Camera: Topcon TRC-50DX, pupil-dilated, 50-degree field of view, 2228 by 1652 pixels:
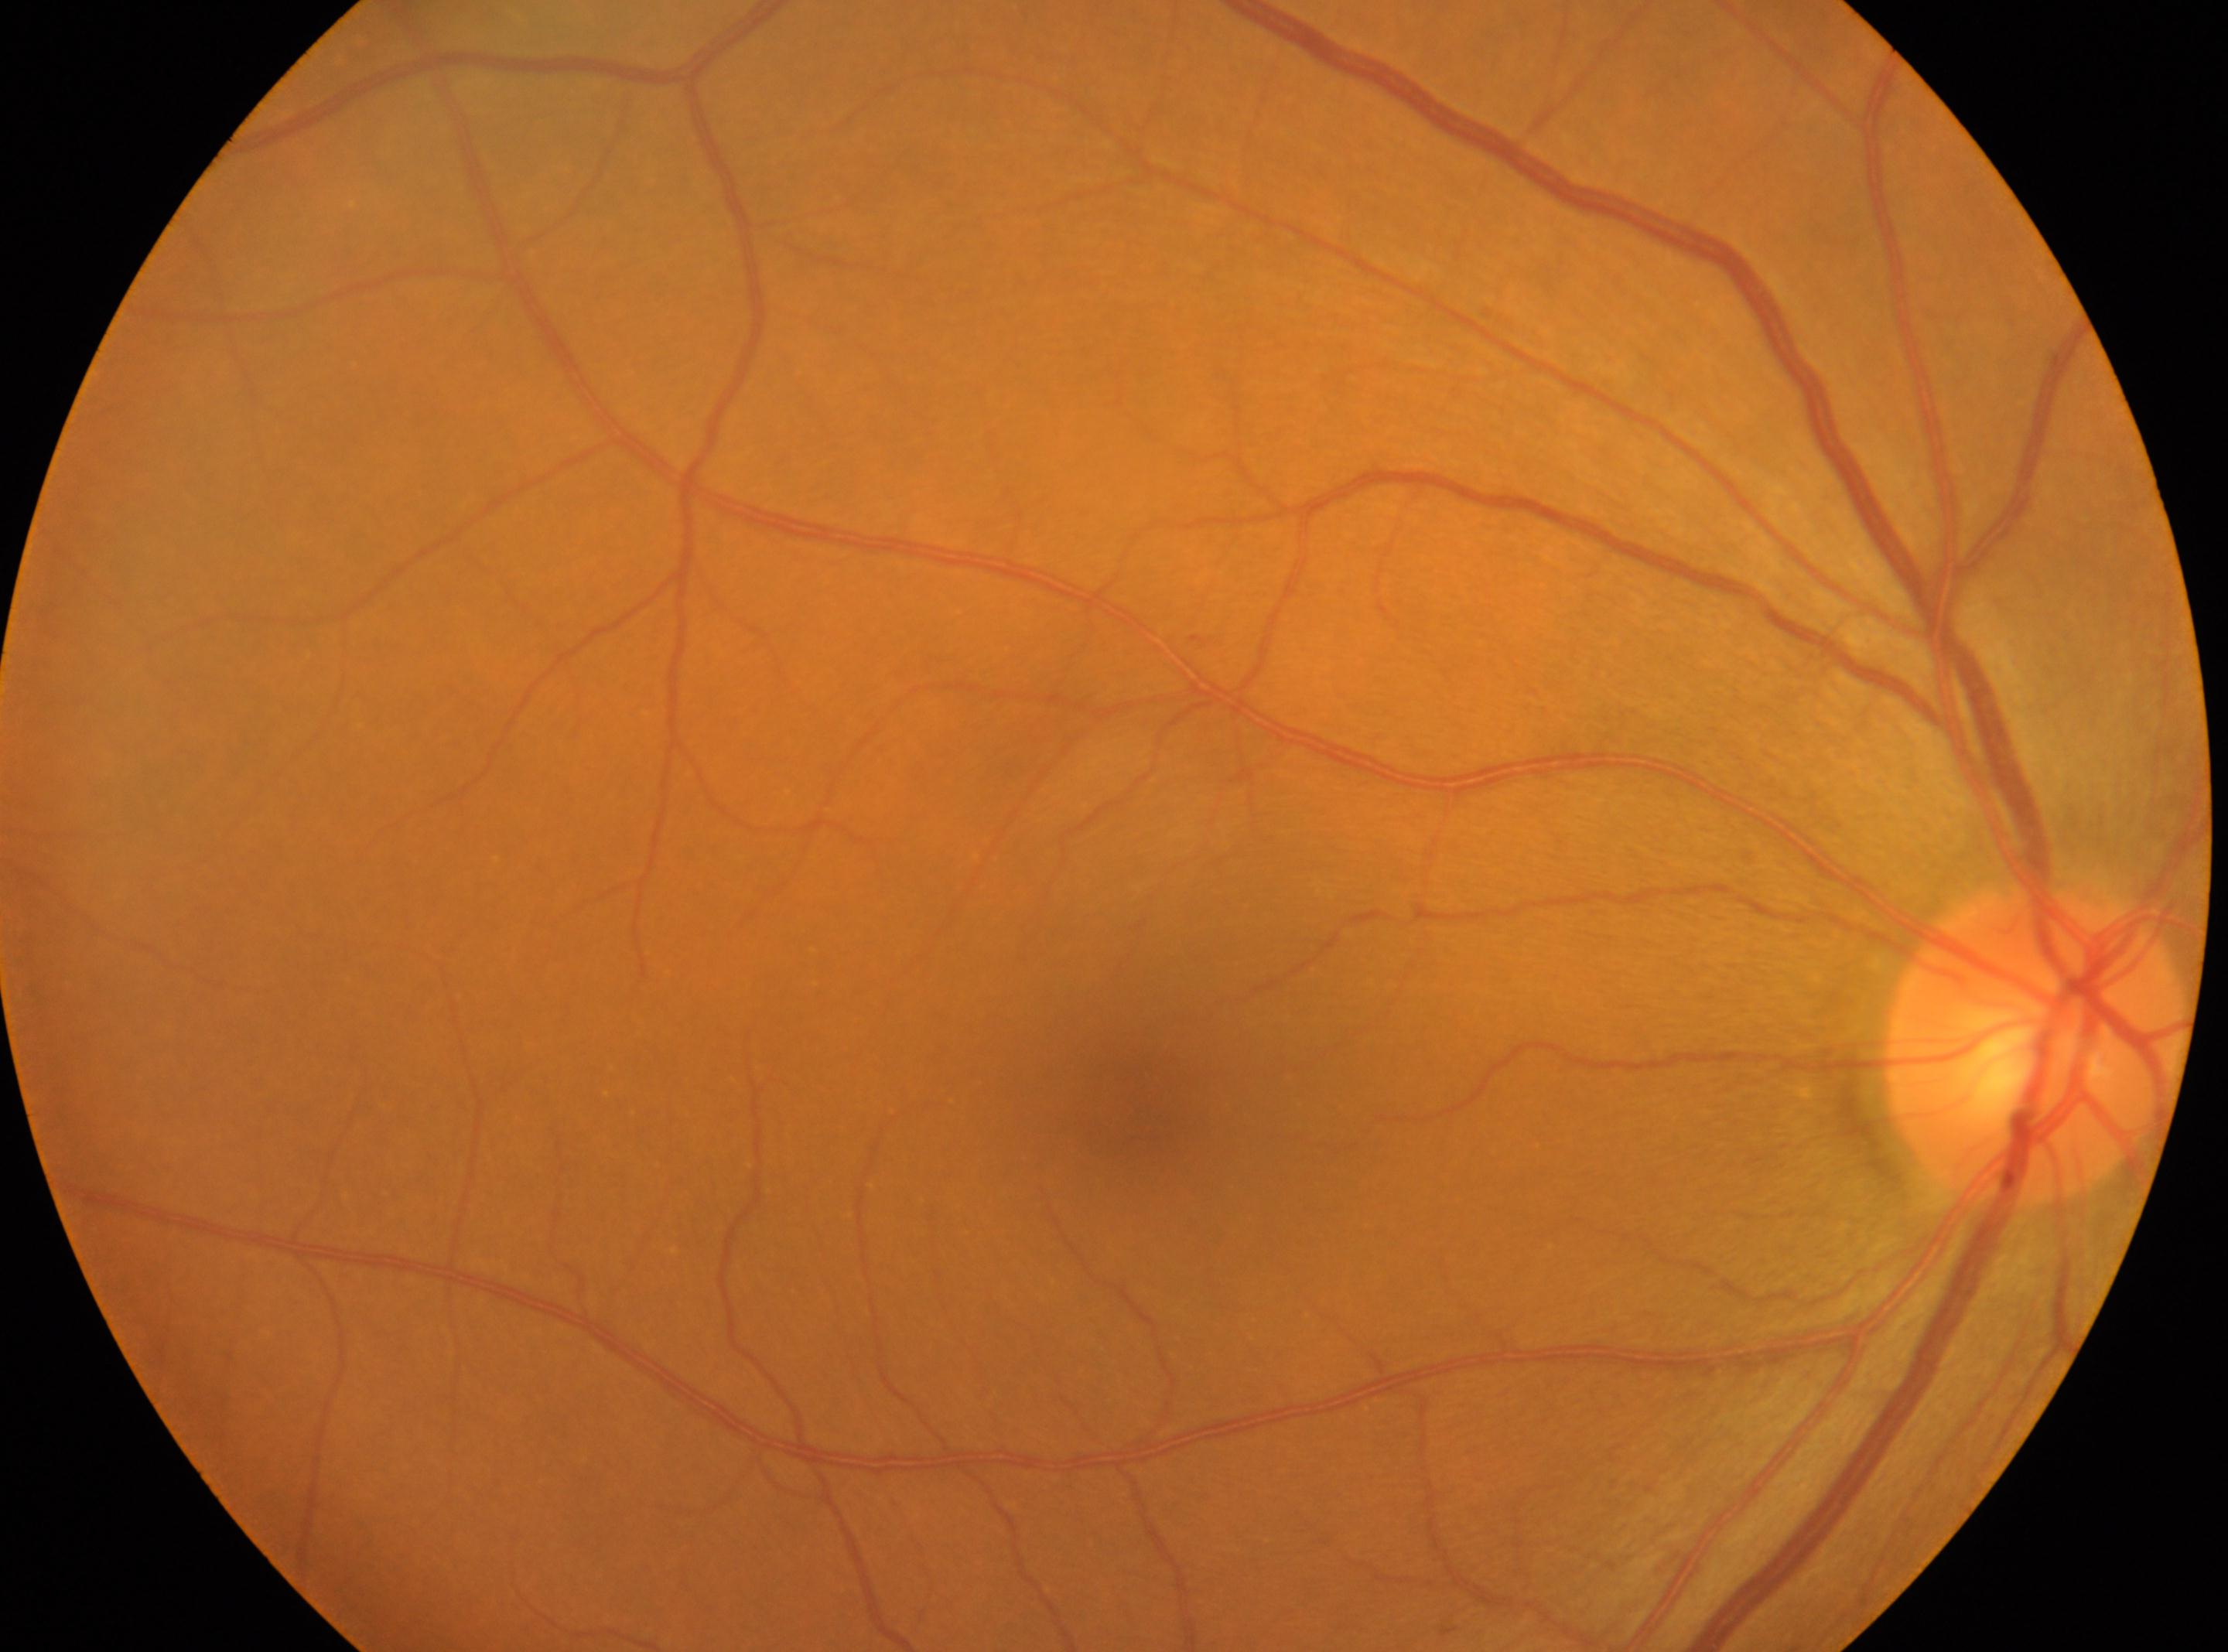
{"eye": "right eye", "optic_disc": "2035, 1043", "dr_grade": "0", "fovea": "1139, 1118"}